640 x 480 pixels. RetCam wide-field infant fundus image:
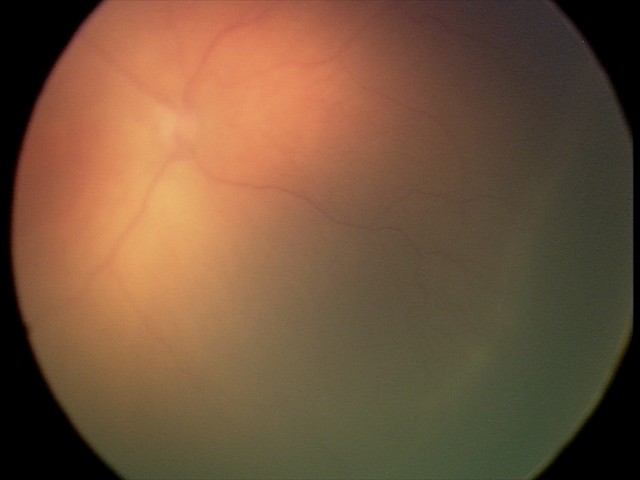 Assessment: retinopathy of prematurity stage 1 — demarcation line between vascular and avascular retina | no plus disease.